Davis DR grading.
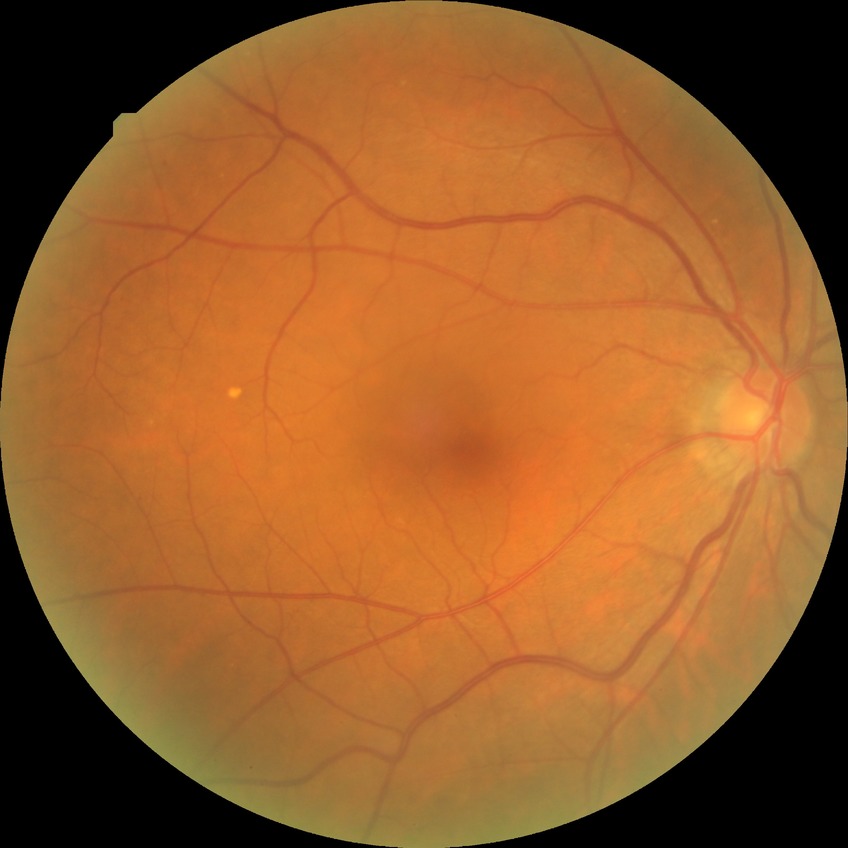

  davis_grade: simple diabetic retinopathy (SDR)